640 by 480 pixels · wide-field fundus image from infant ROP screening:
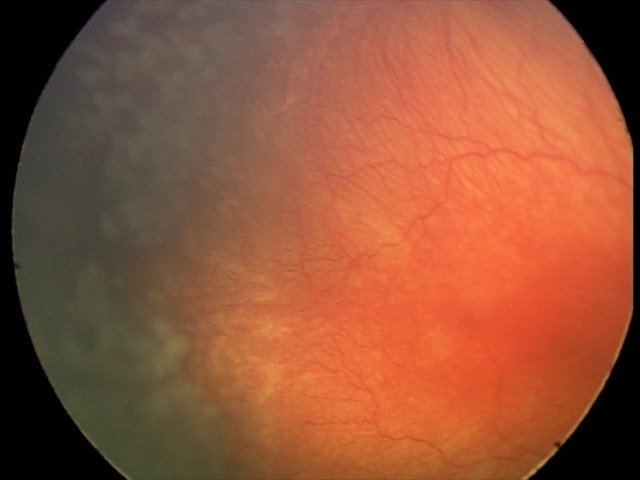

Q: What was the screening finding?
A: A-ROP (aggressive ROP)
Q: What is the plus-form classification?
A: plus disease